45-degree field of view; 848 x 848 pixels; retinal fundus photograph — 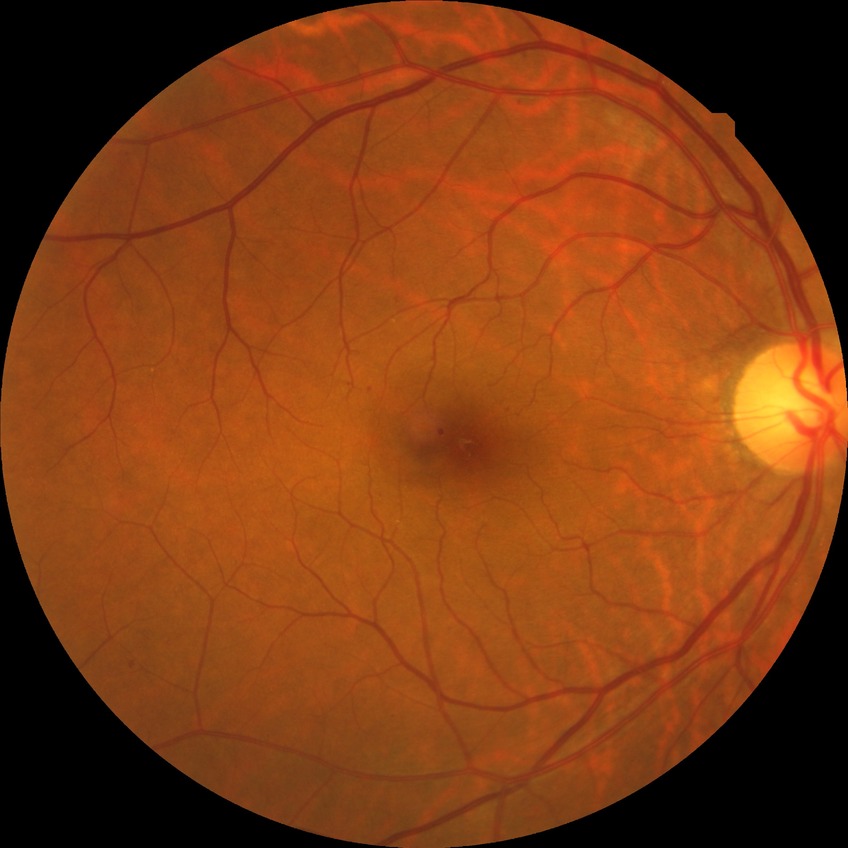

DR stage: SDR.